2352 x 1568 pixels
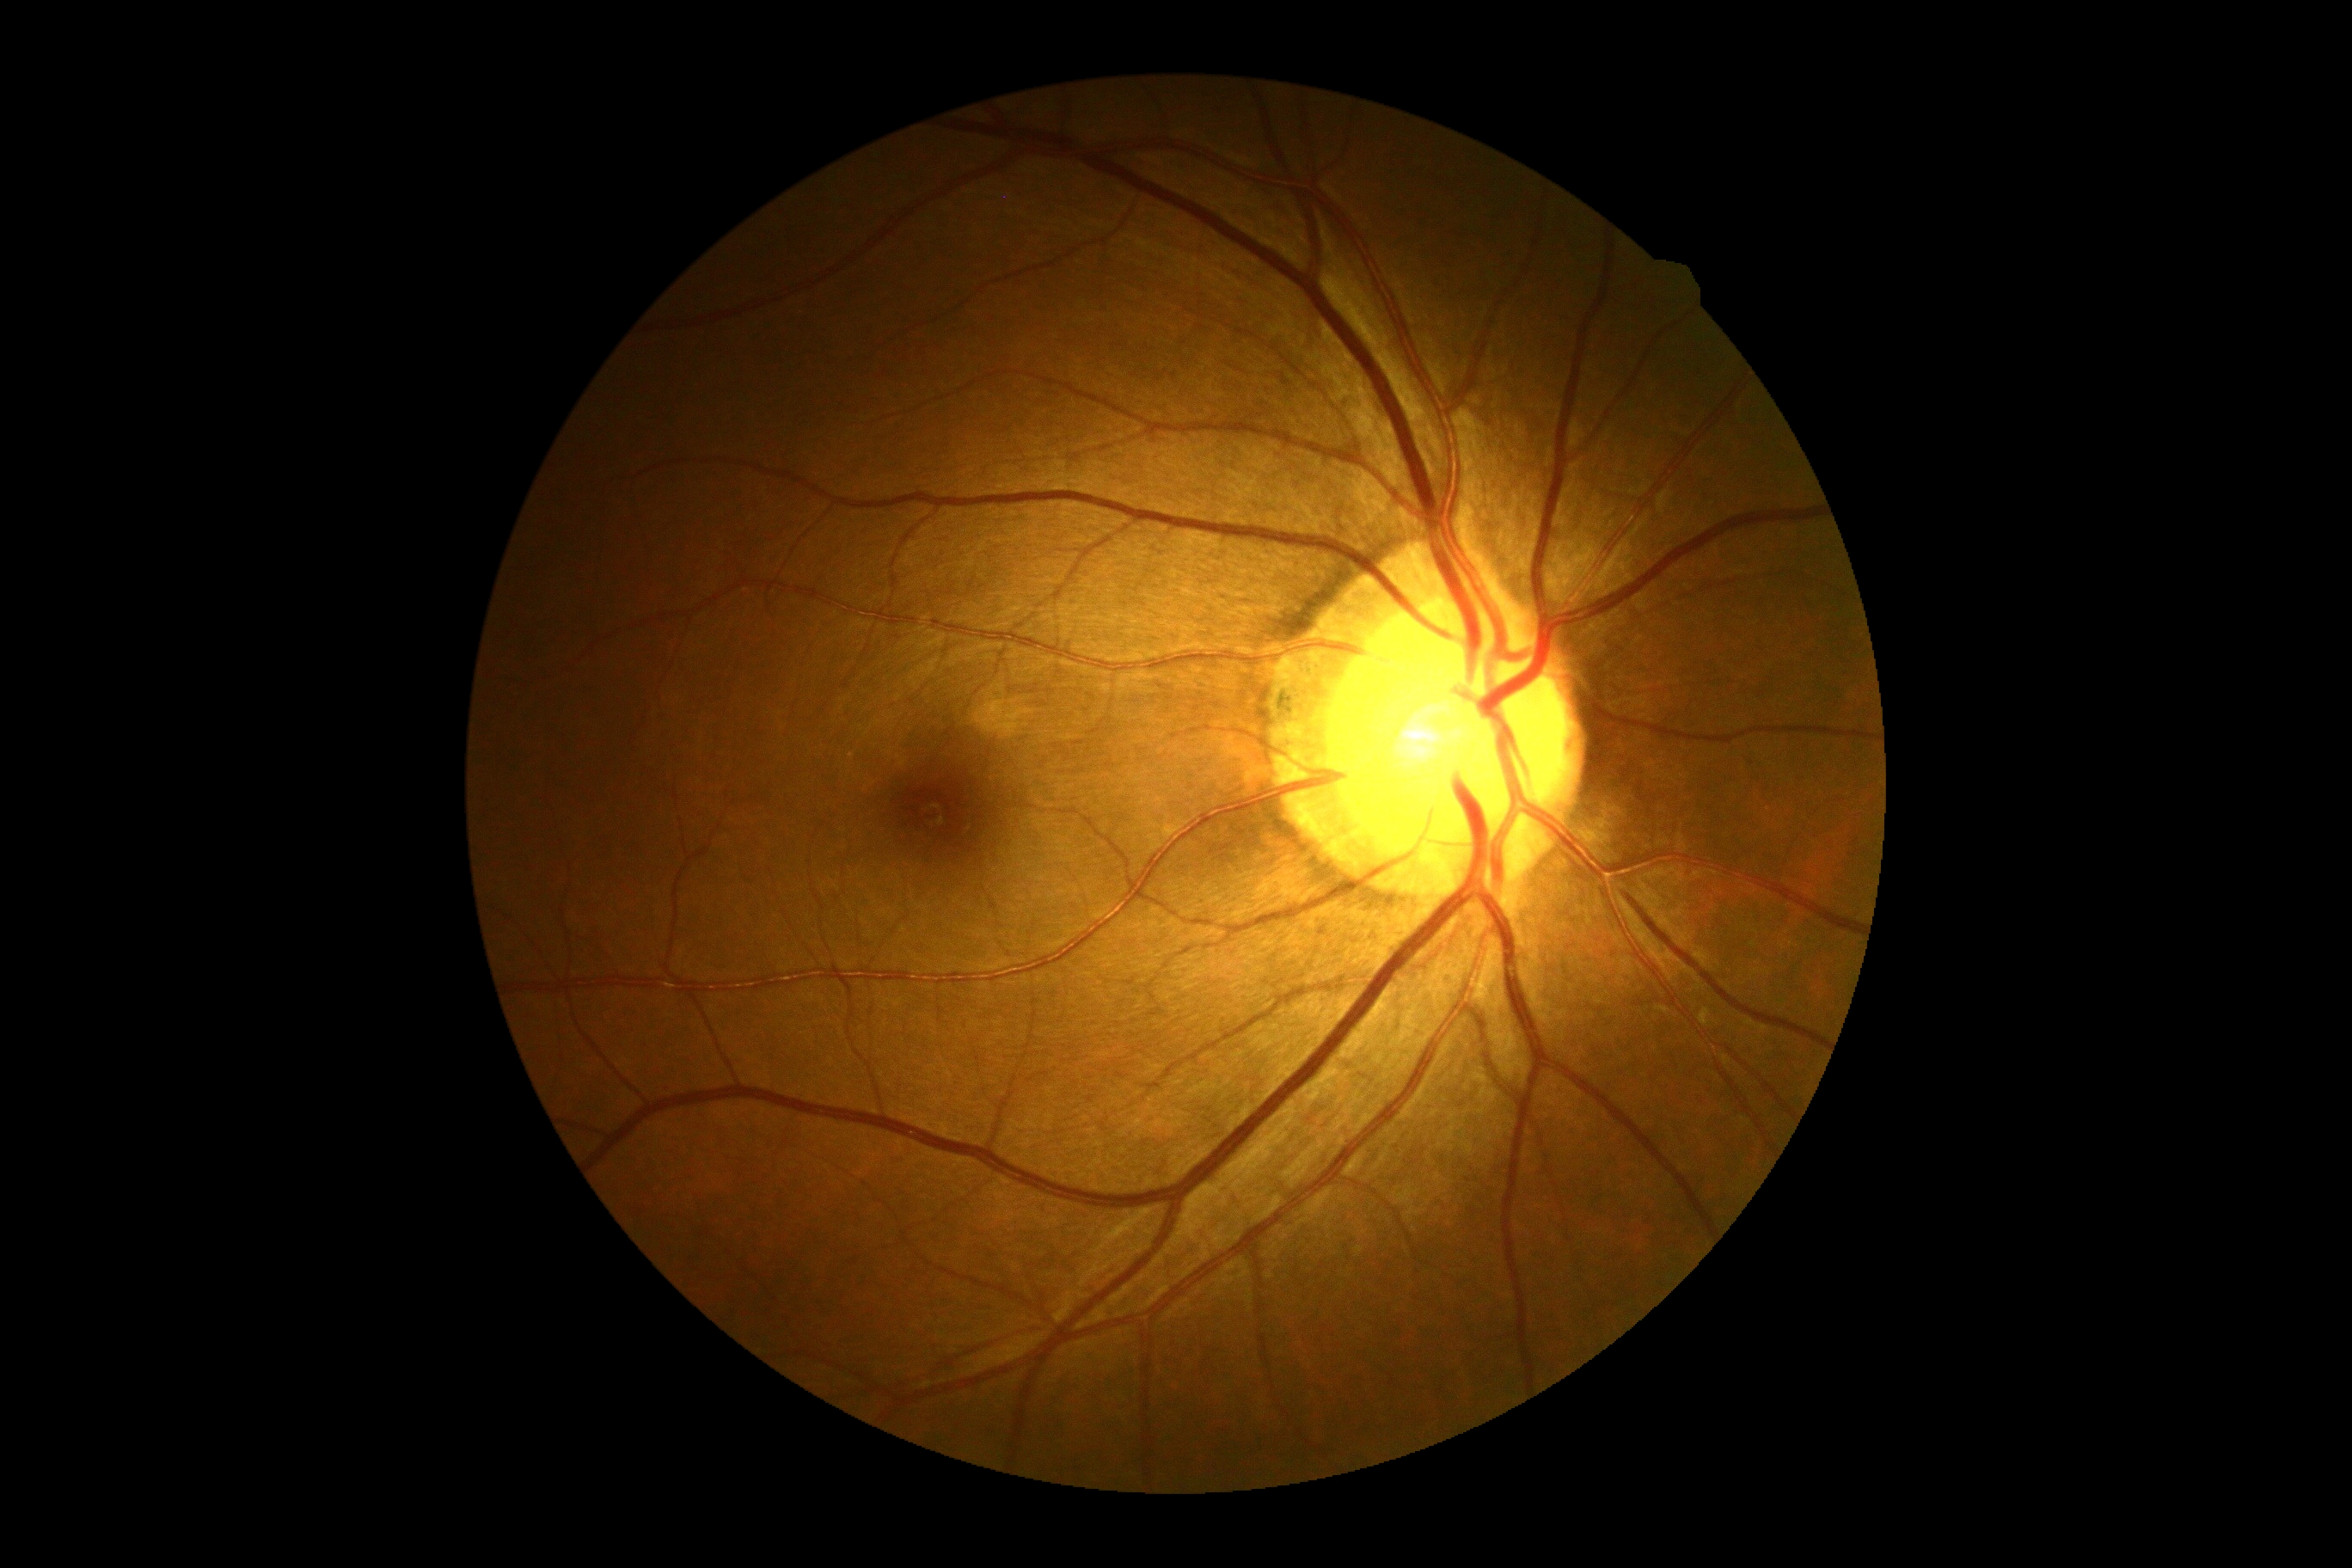

DR impression: negative for DR | DR grade: no apparent retinopathy (0).